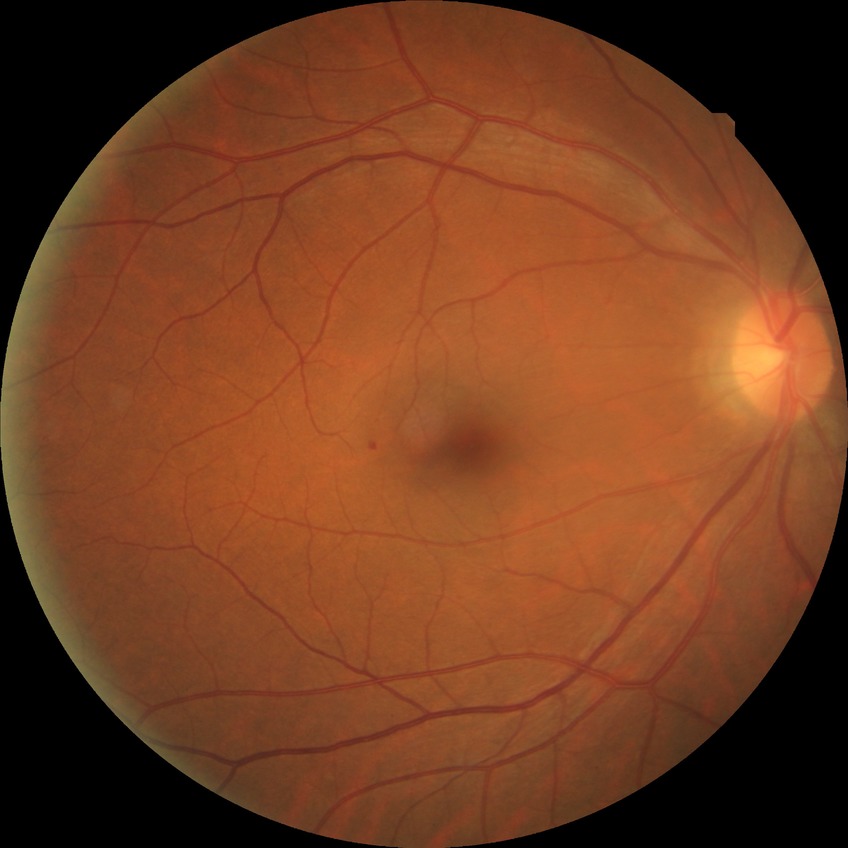
Modified Davis classification is simple diabetic retinopathy.